Nonmydriatic: 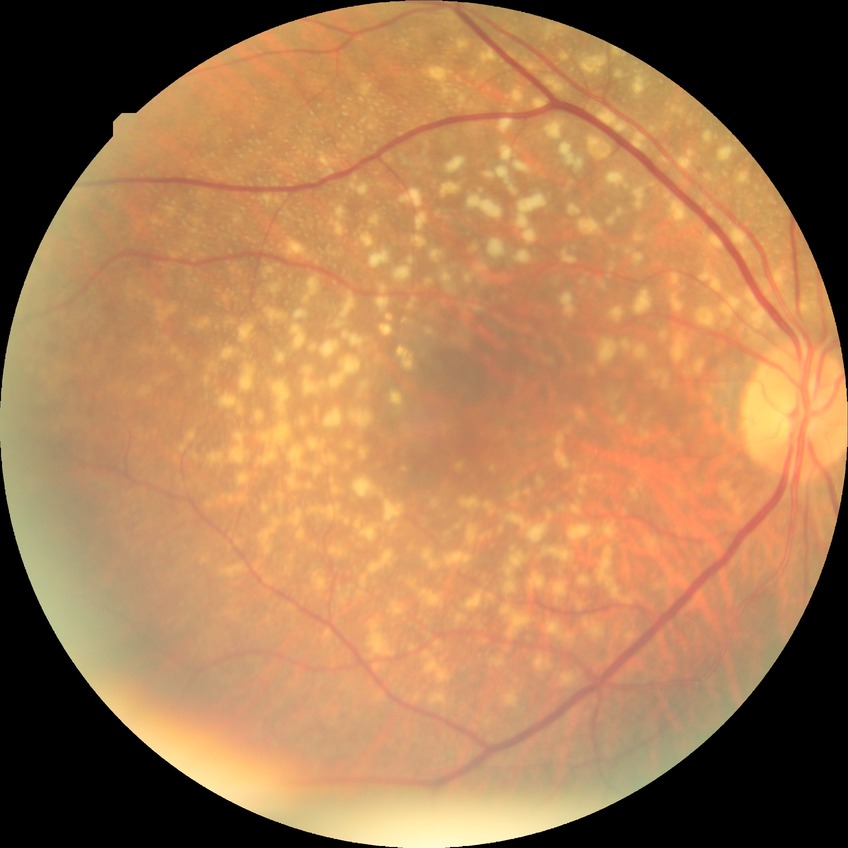
{
  "davis_grade": "NDR (no diabetic retinopathy)"
}